640 x 480 pixels; wide-field contact fundus photograph of an infant
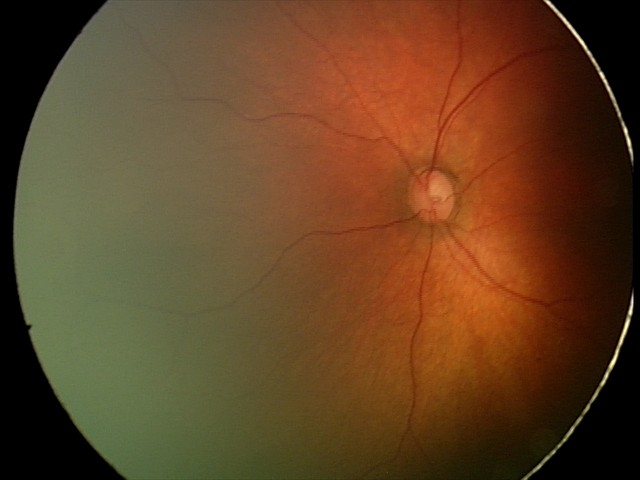
Screening examination diagnosed as physiological.